Color fundus photograph
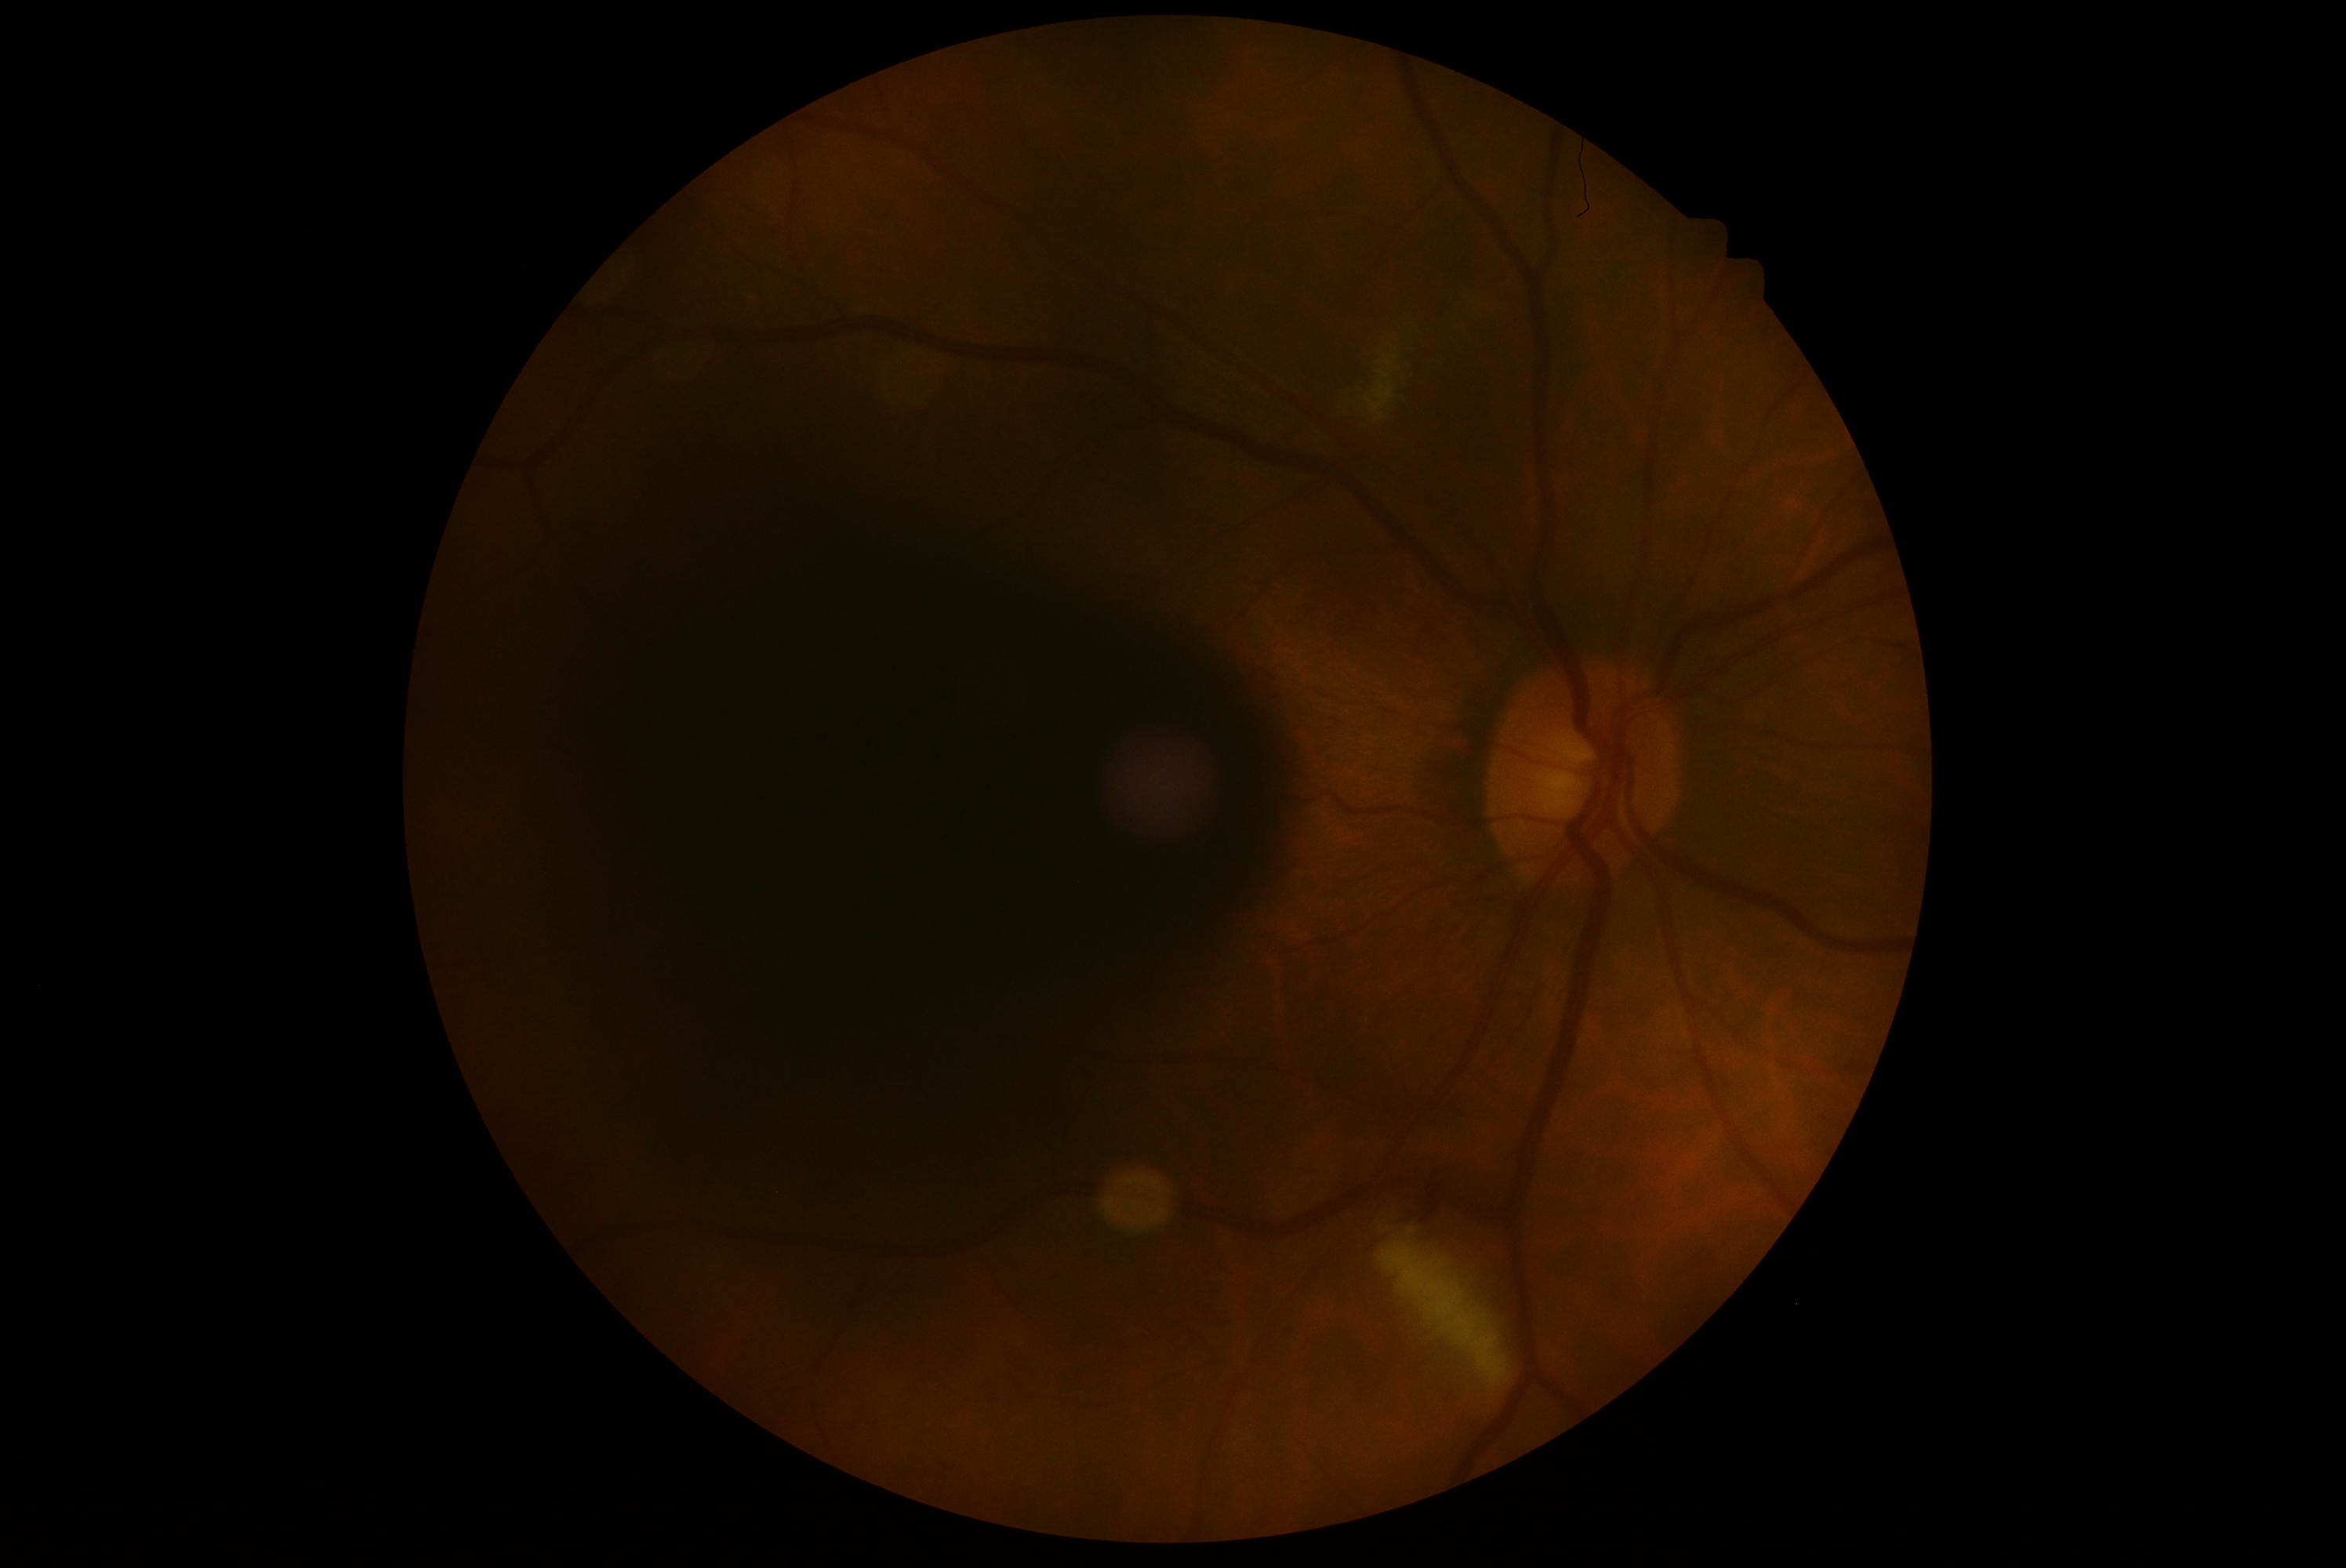 {
  "dr_category": "non-proliferative diabetic retinopathy",
  "dr_grade": "grade 2 (moderate NPDR) — more than just microaneurysms but less than severe NPDR"
}